Modified Davis grading — 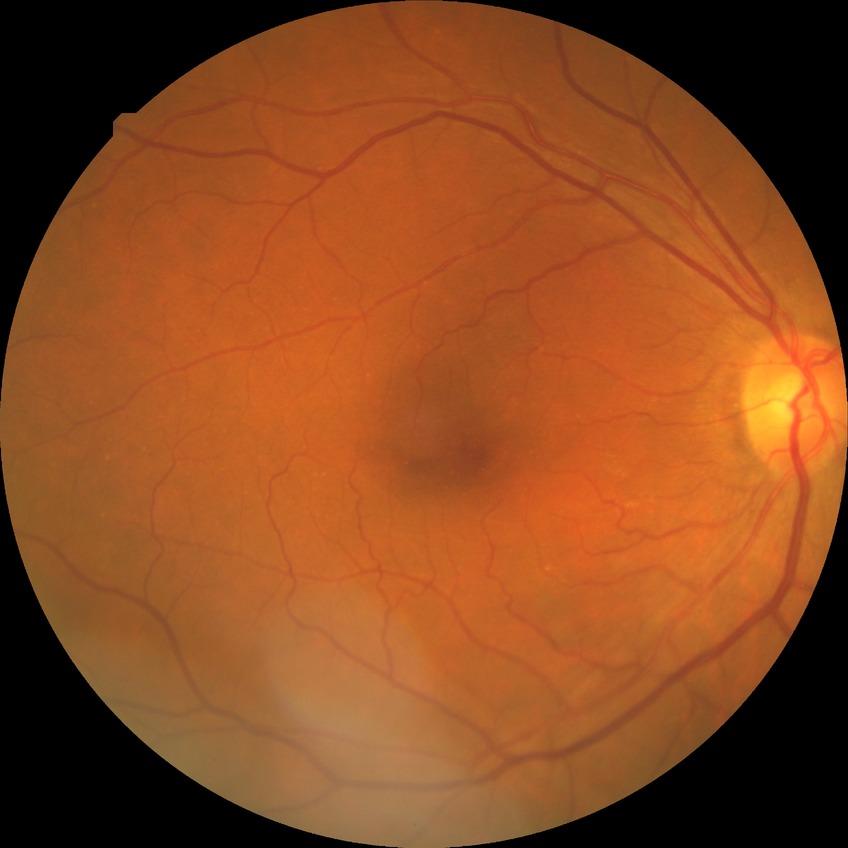 diabetic retinopathy (DR) = NDR (no diabetic retinopathy).